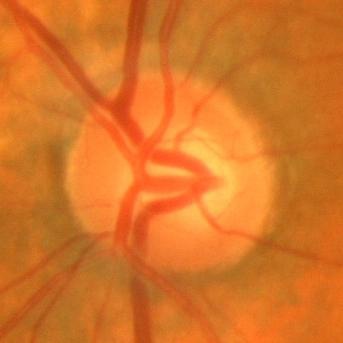

Disc-centered fundus crop showing no glaucomatous optic neuropathy.